Retinal fundus photograph: 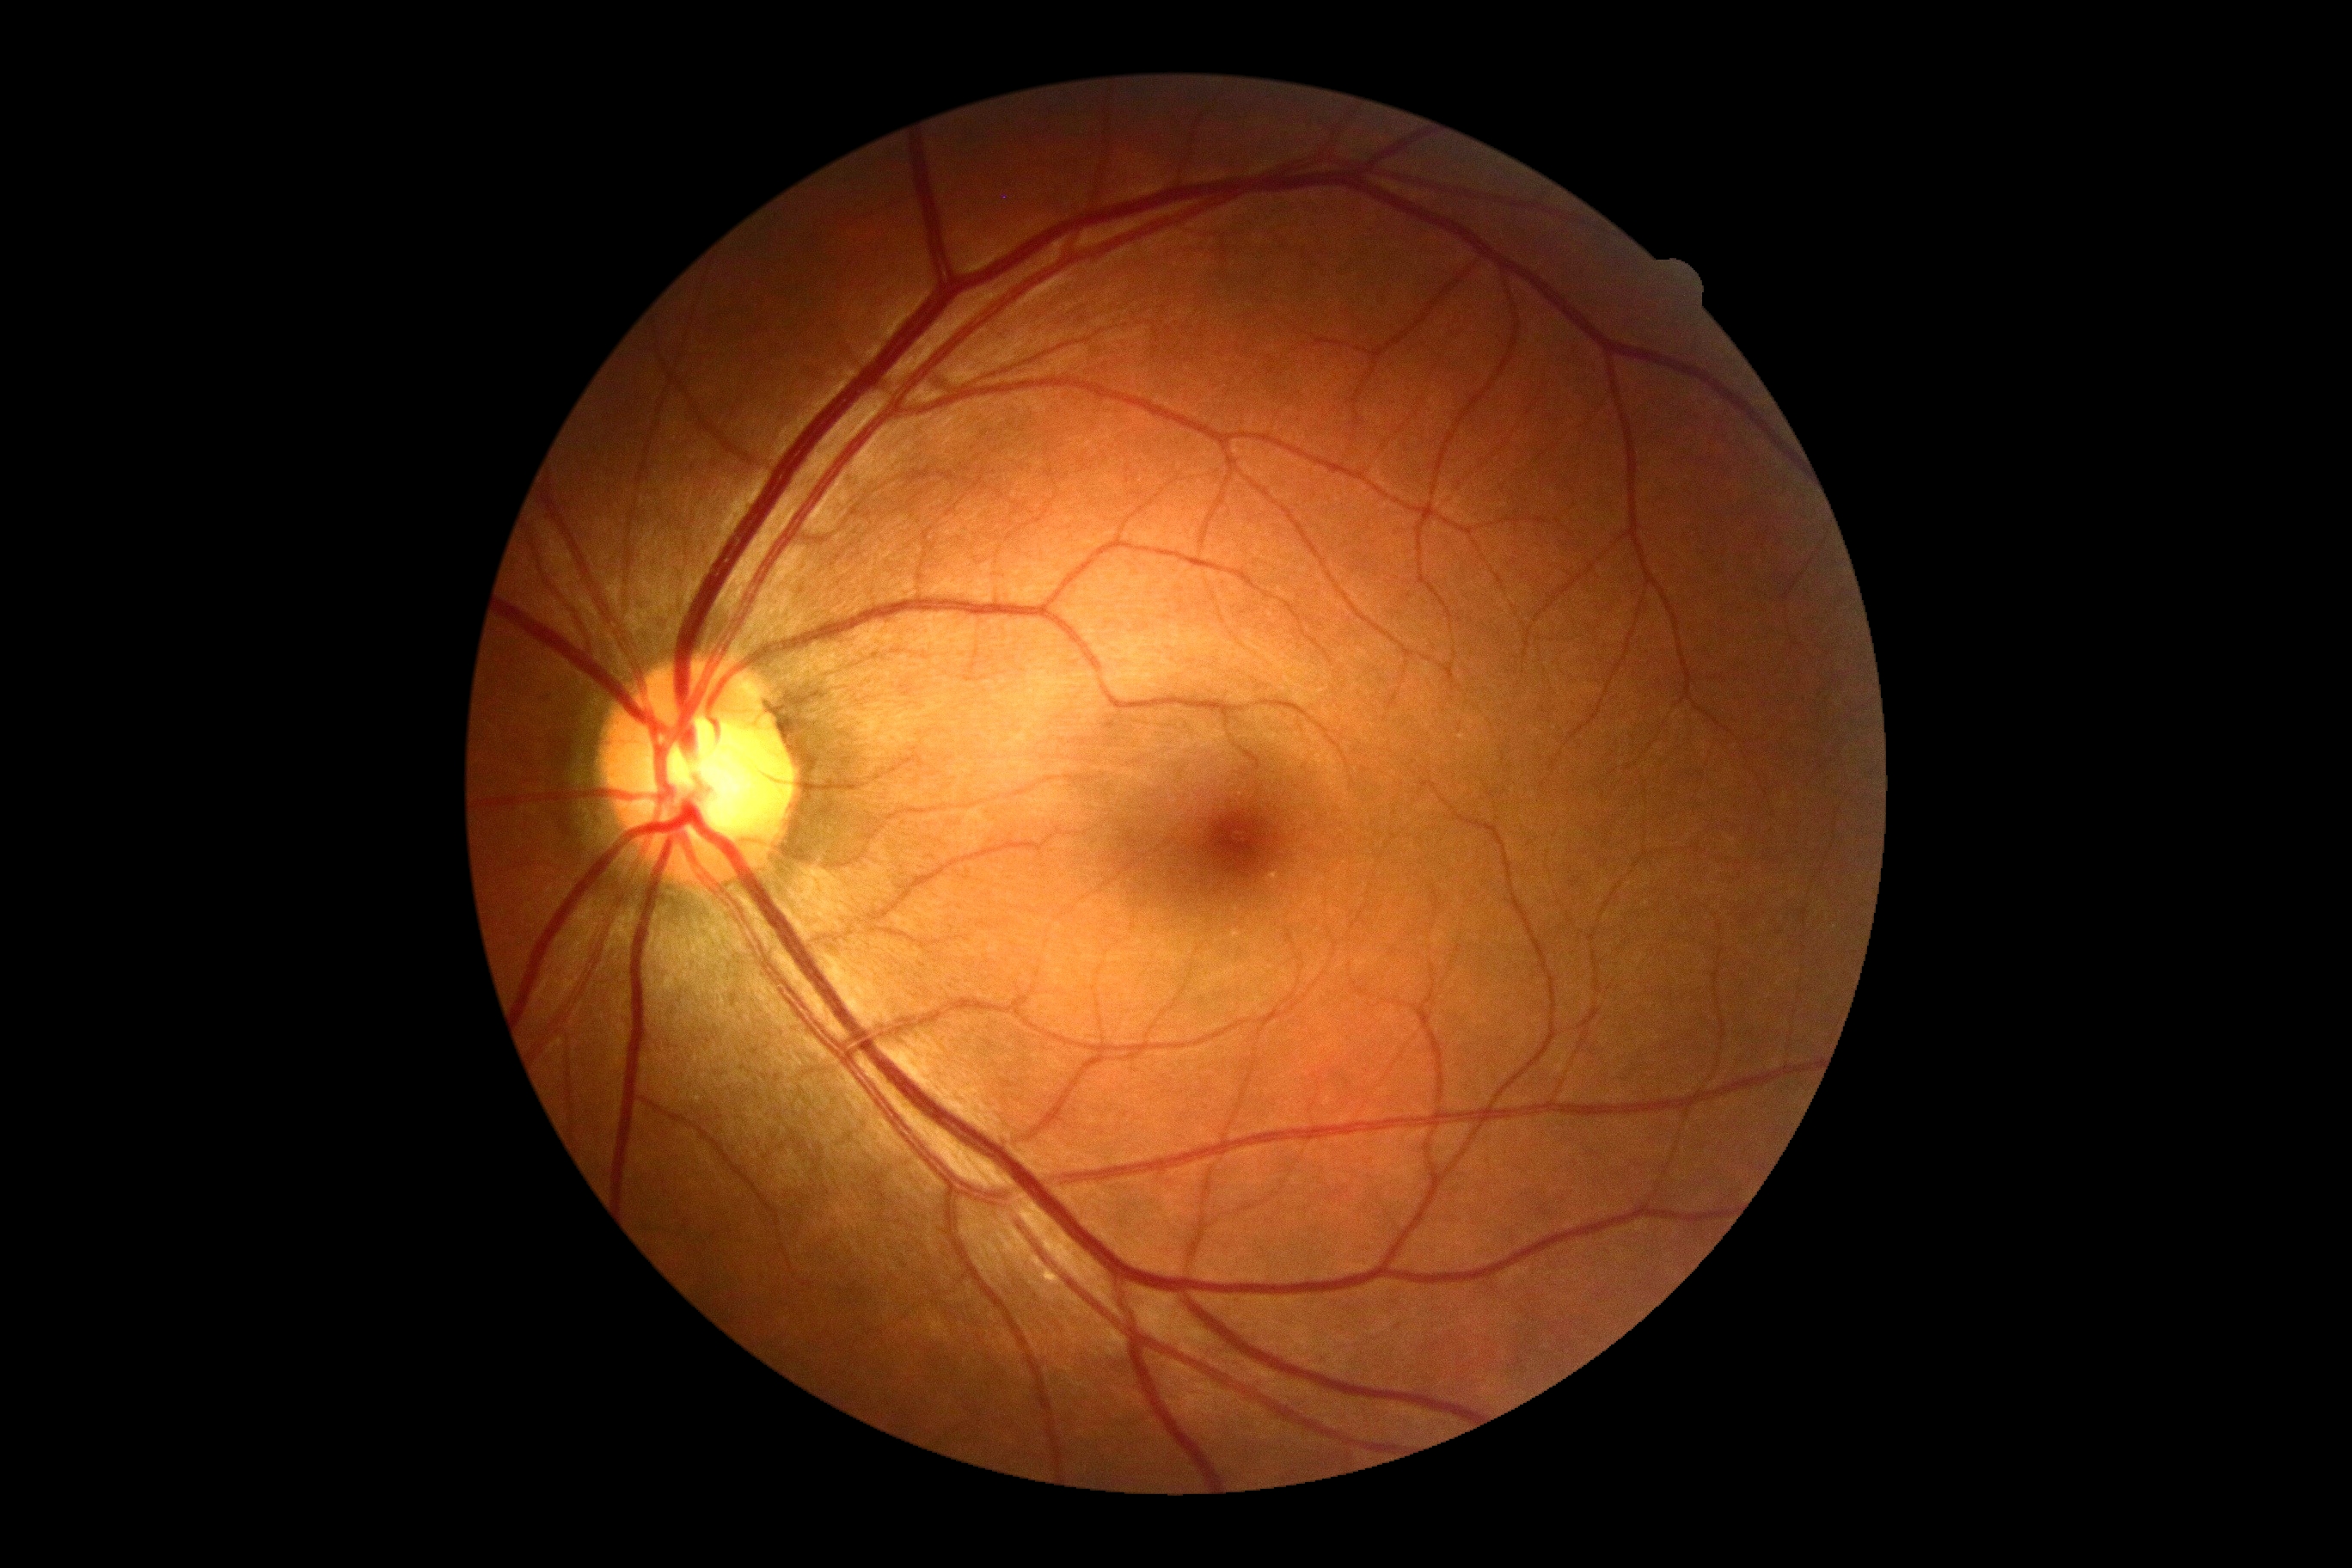 DR impression = no DR findings; DR grade = 0/4.